FOV: 45 degrees: 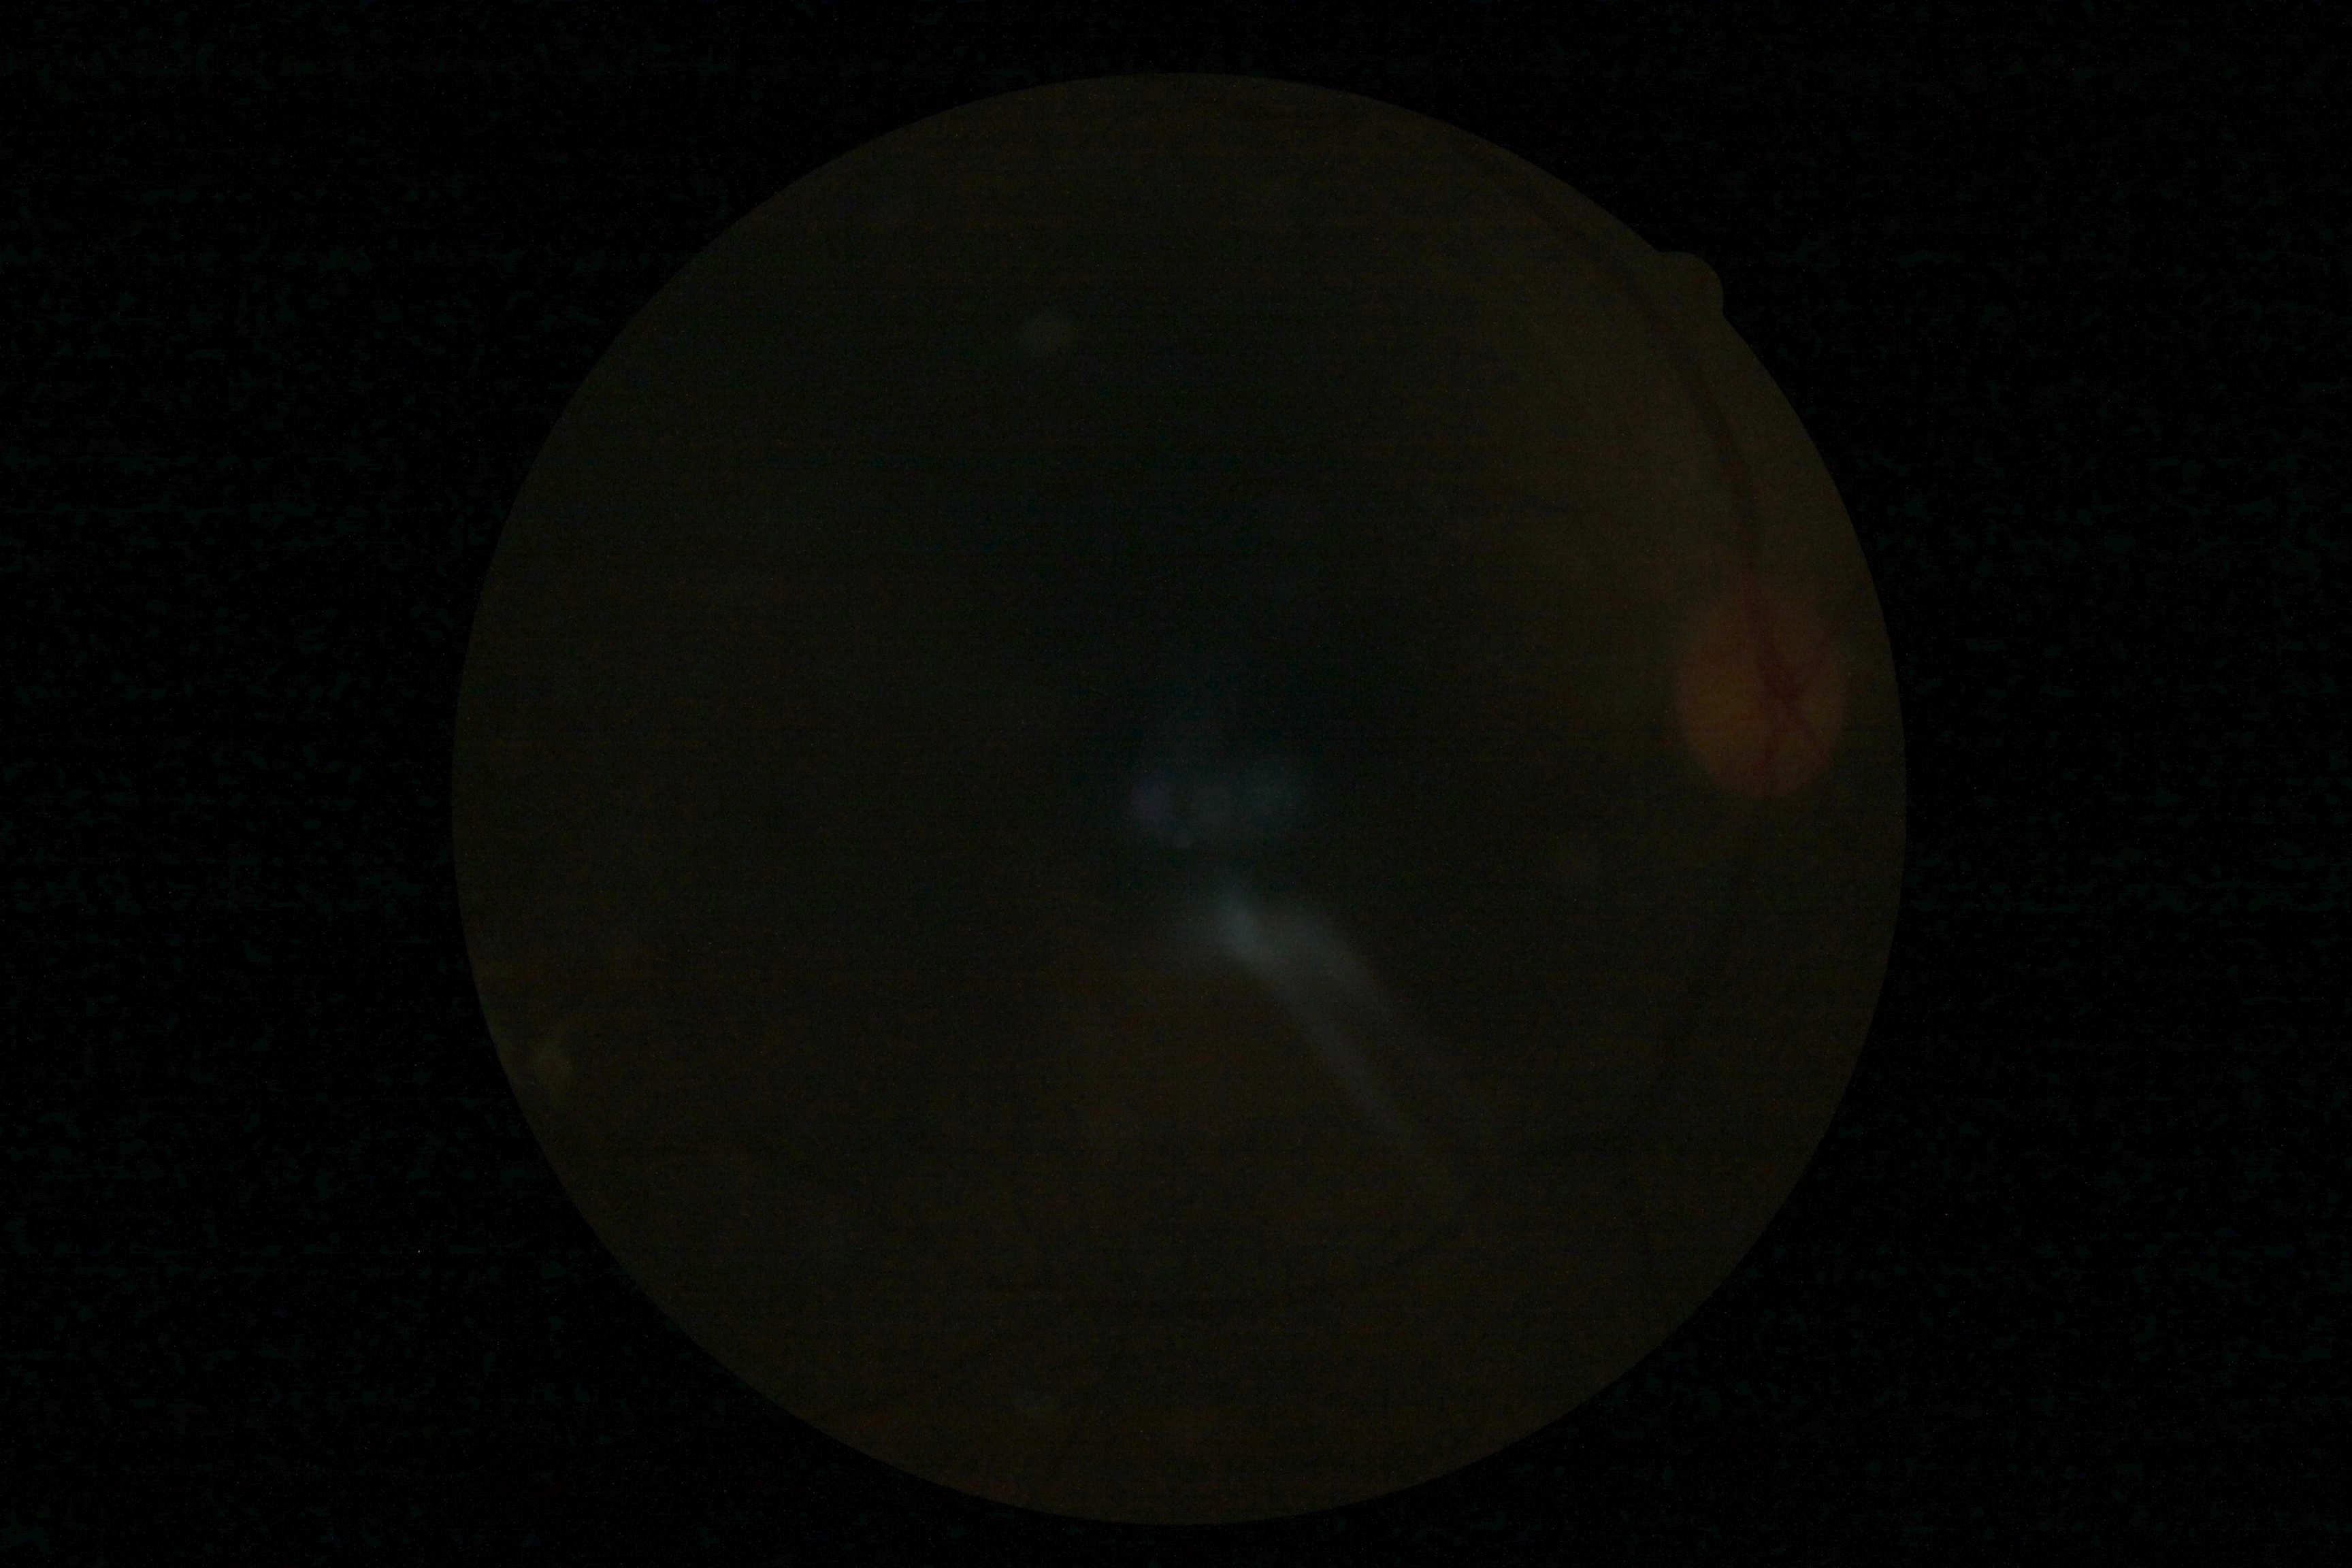
Diabetic retinopathy: ungradable.
Ungradable image — DR severity cannot be determined.